Acquired with a NIDEK AFC-230; color fundus image; nonmydriatic fundus photograph: 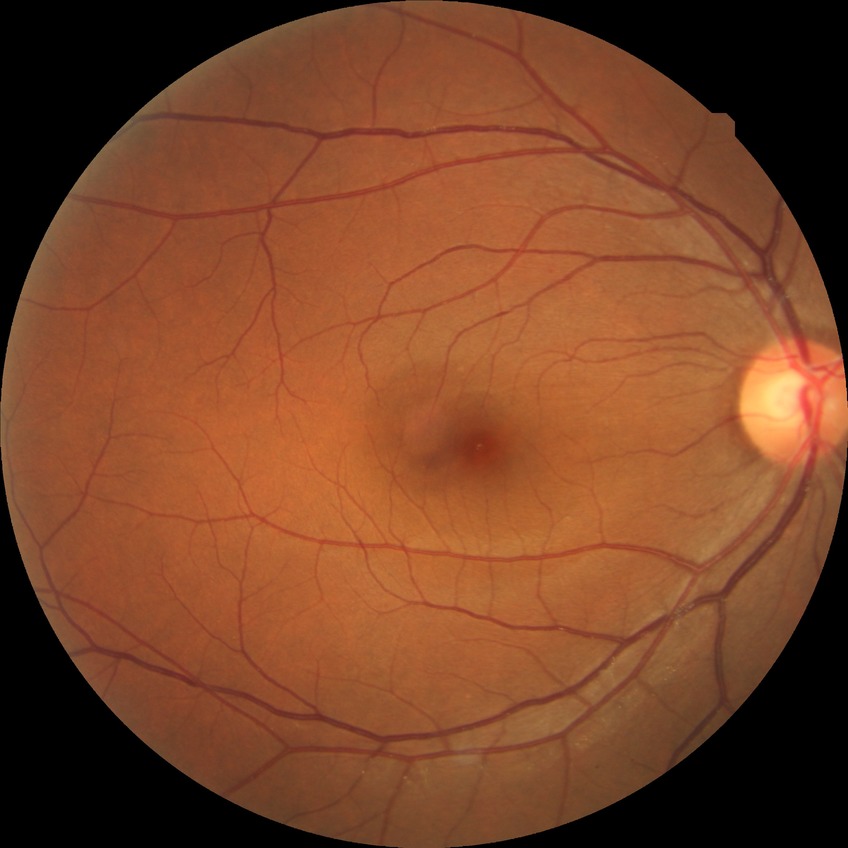 Diabetic retinopathy (DR) is NDR (no diabetic retinopathy).